45° FOV; color fundus photograph; 1932 x 1910 pixels.
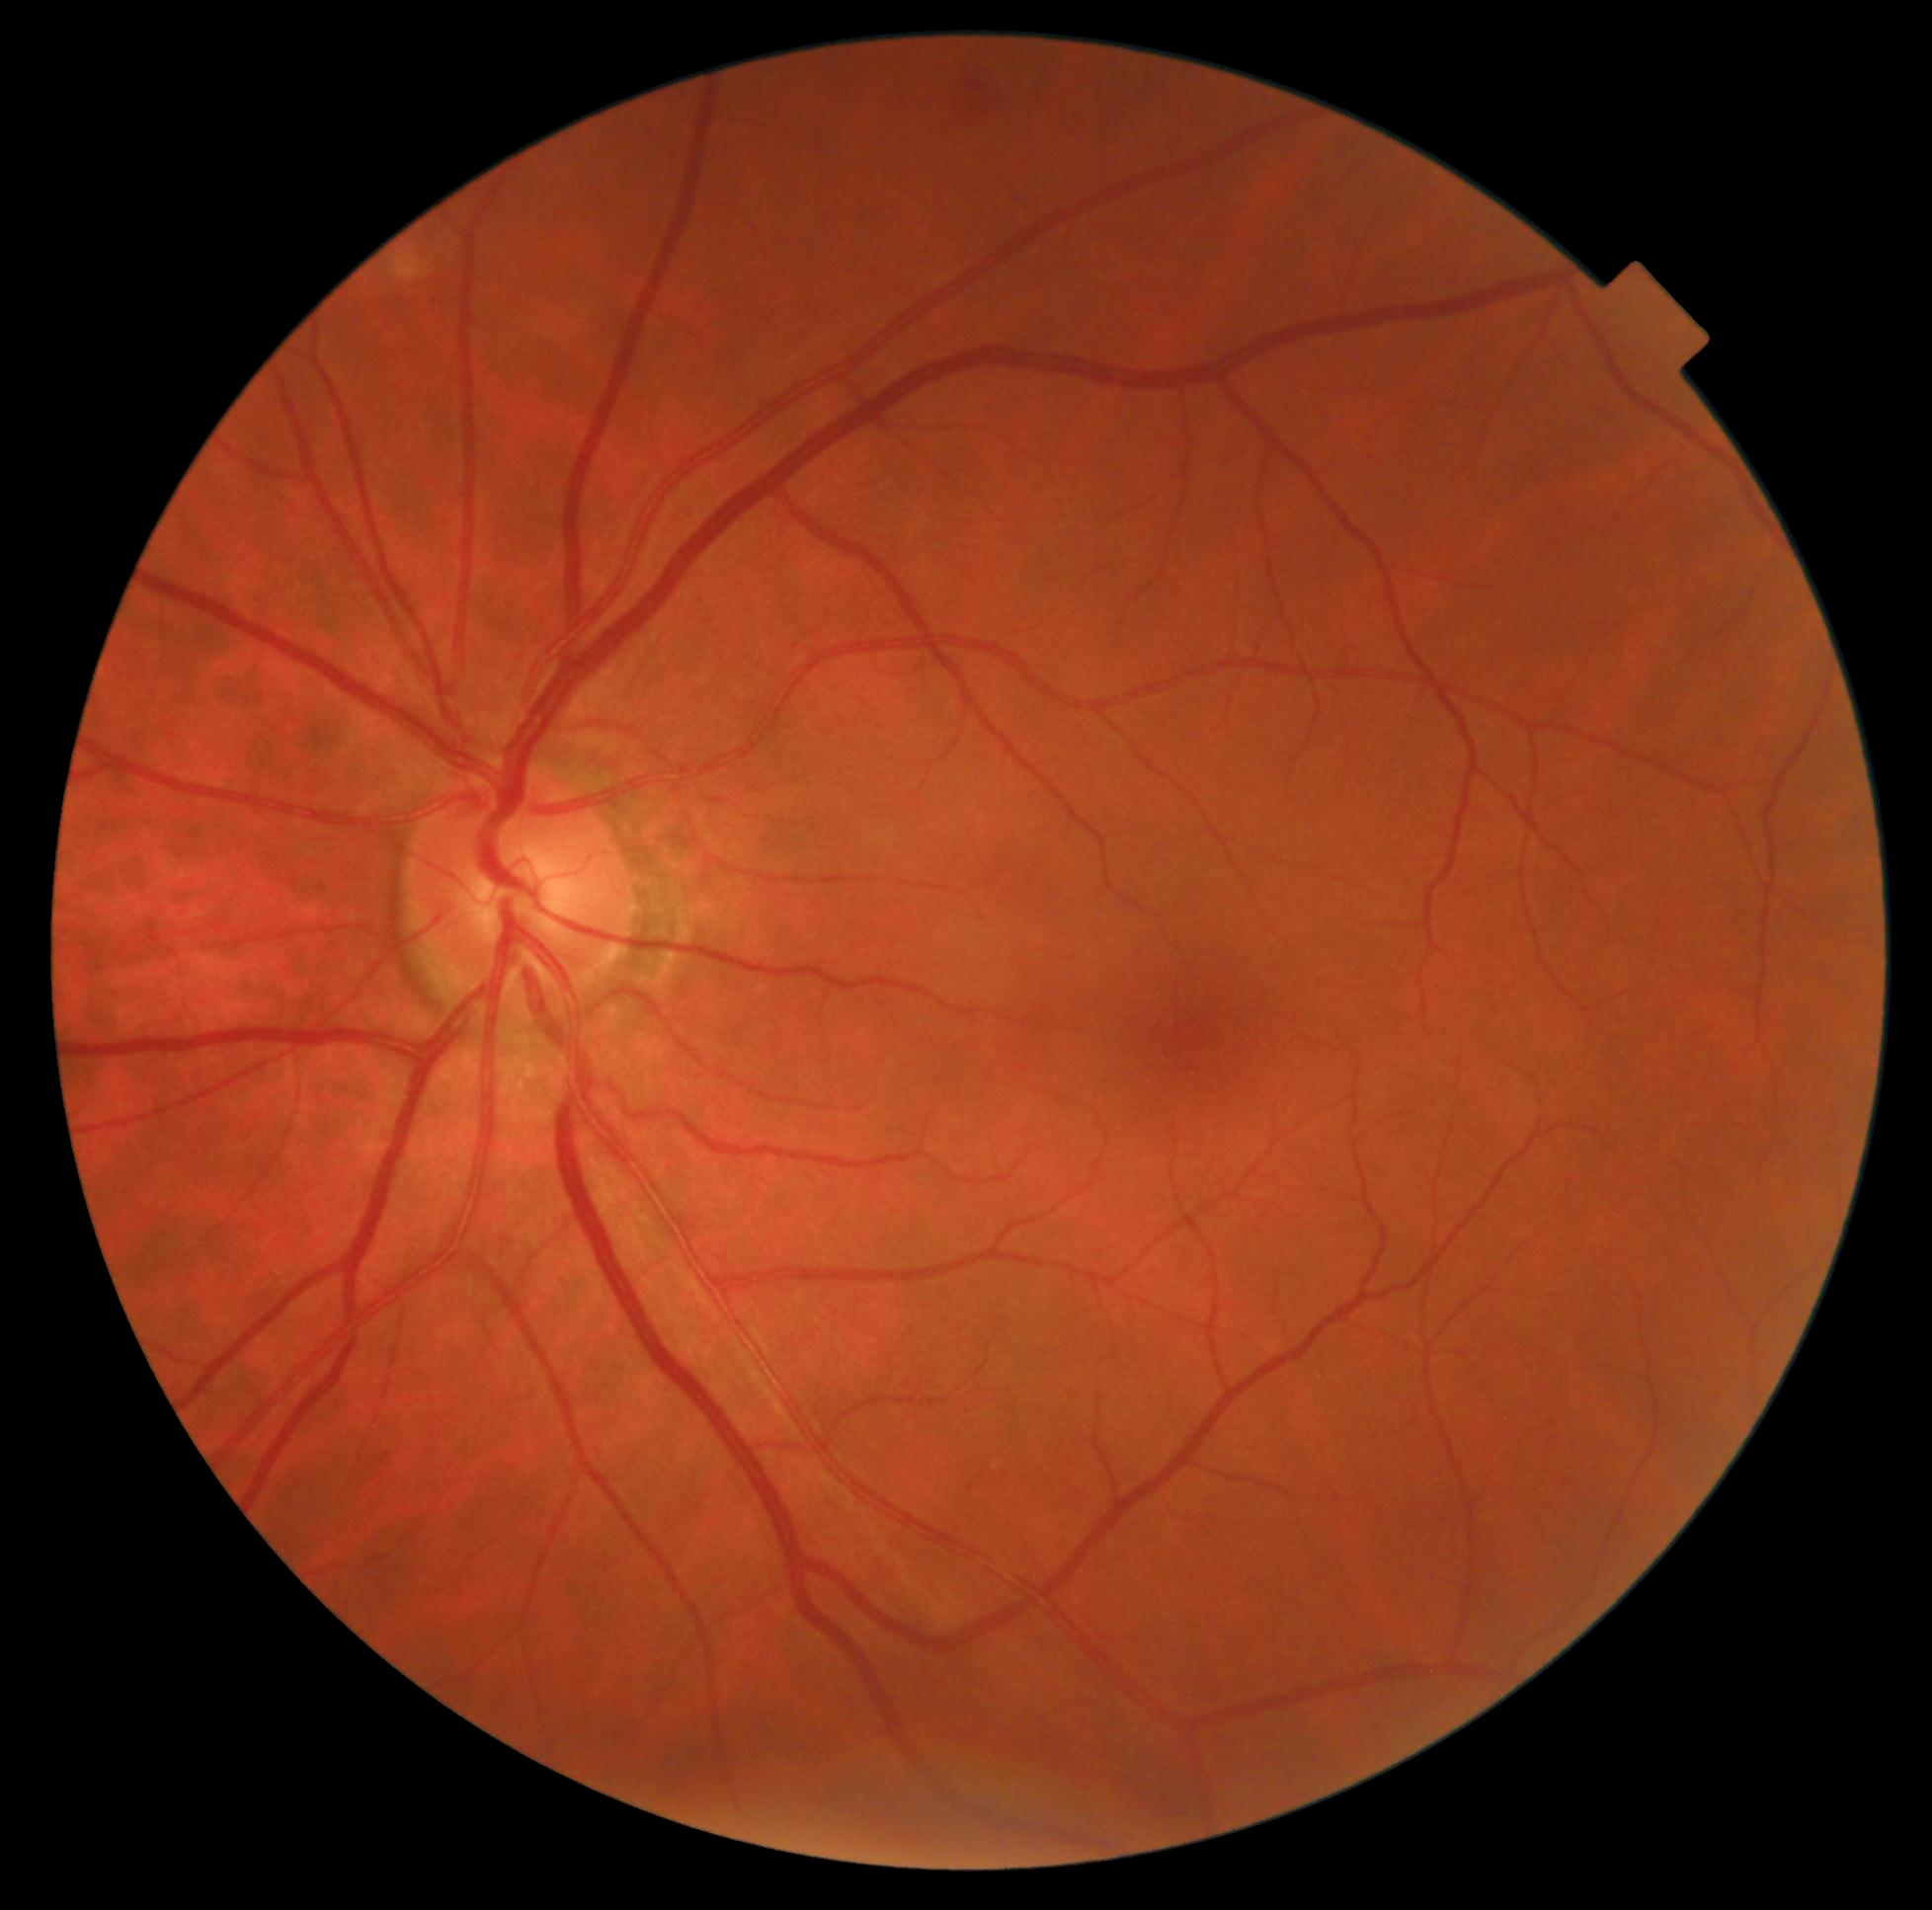 Findings:
* diabetic retinopathy grade: 2